CFP; Topcon TRC-NW8 — 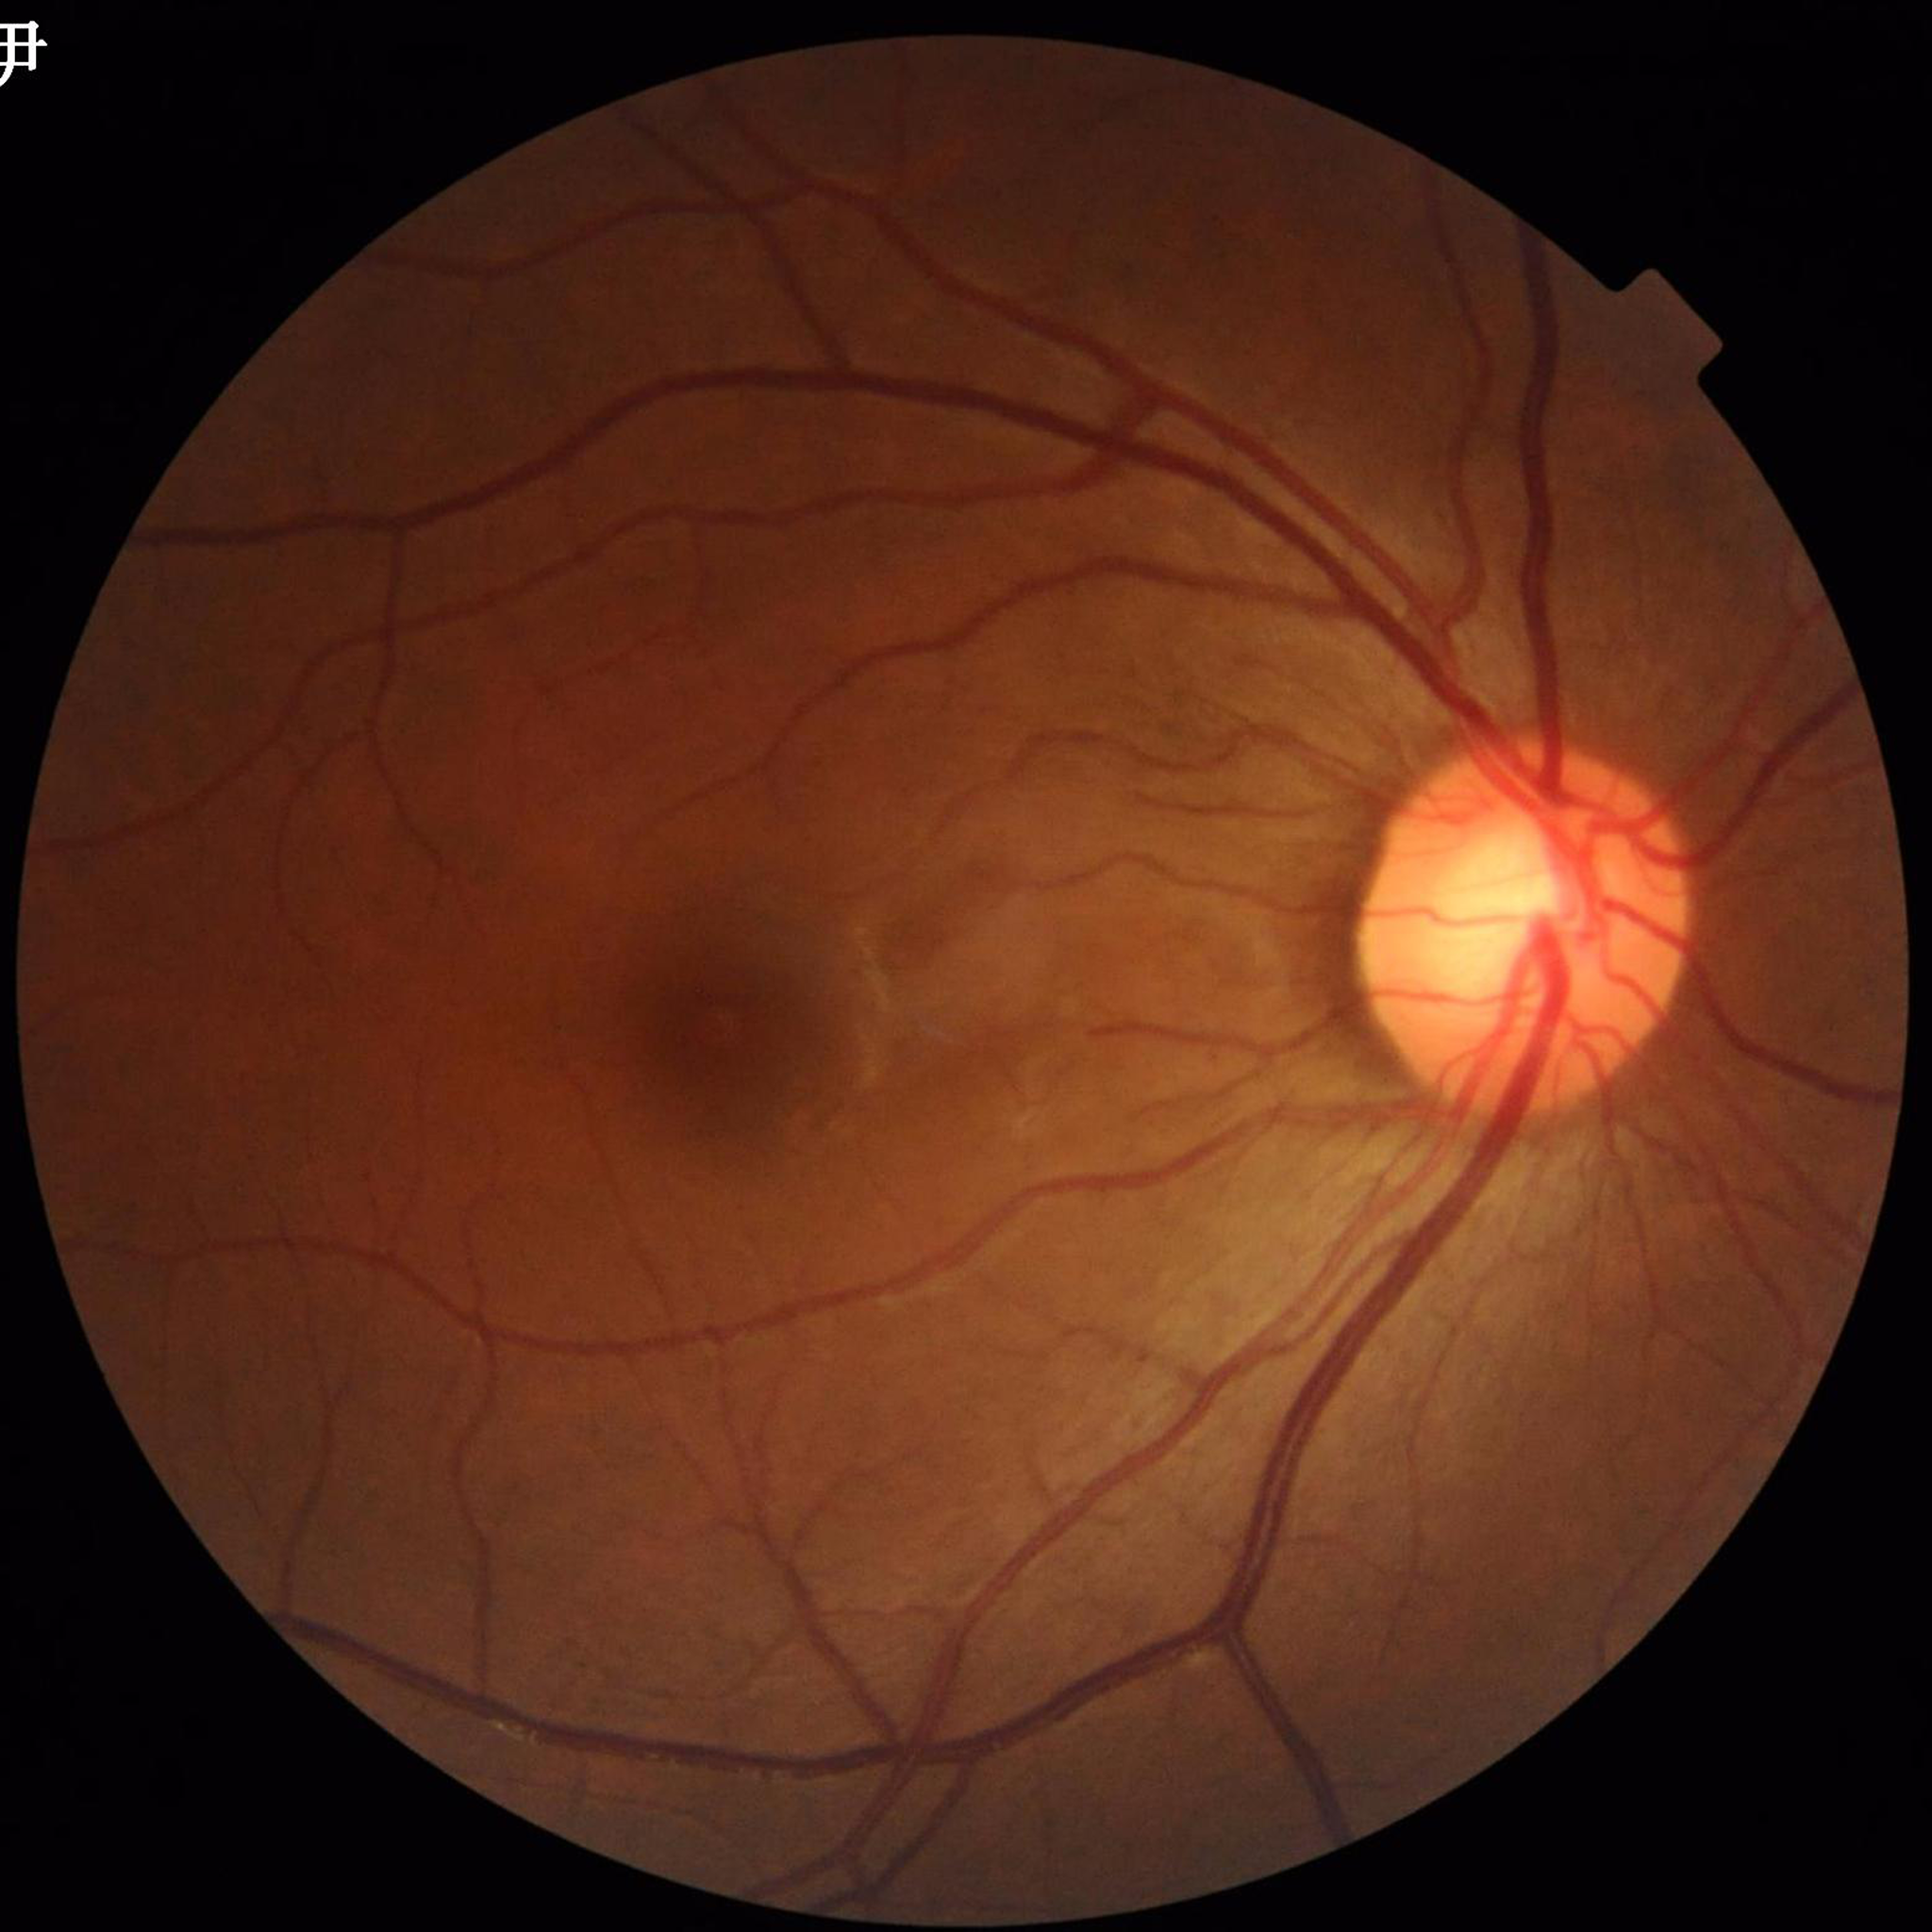
The patient was diagnosed with glaucoma.